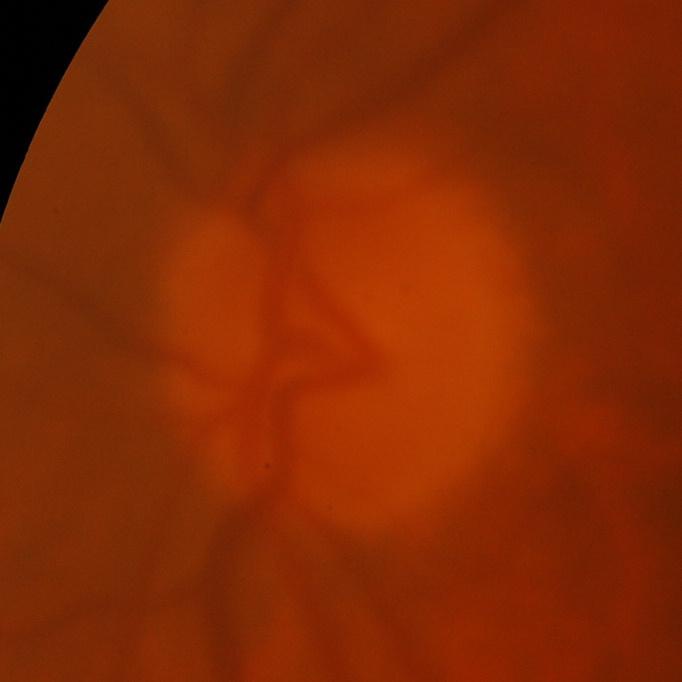
Glaucomatous changes are present. Disc-centered fundus crop showing glaucomatous findings.